Wide-field fundus photograph of an infant
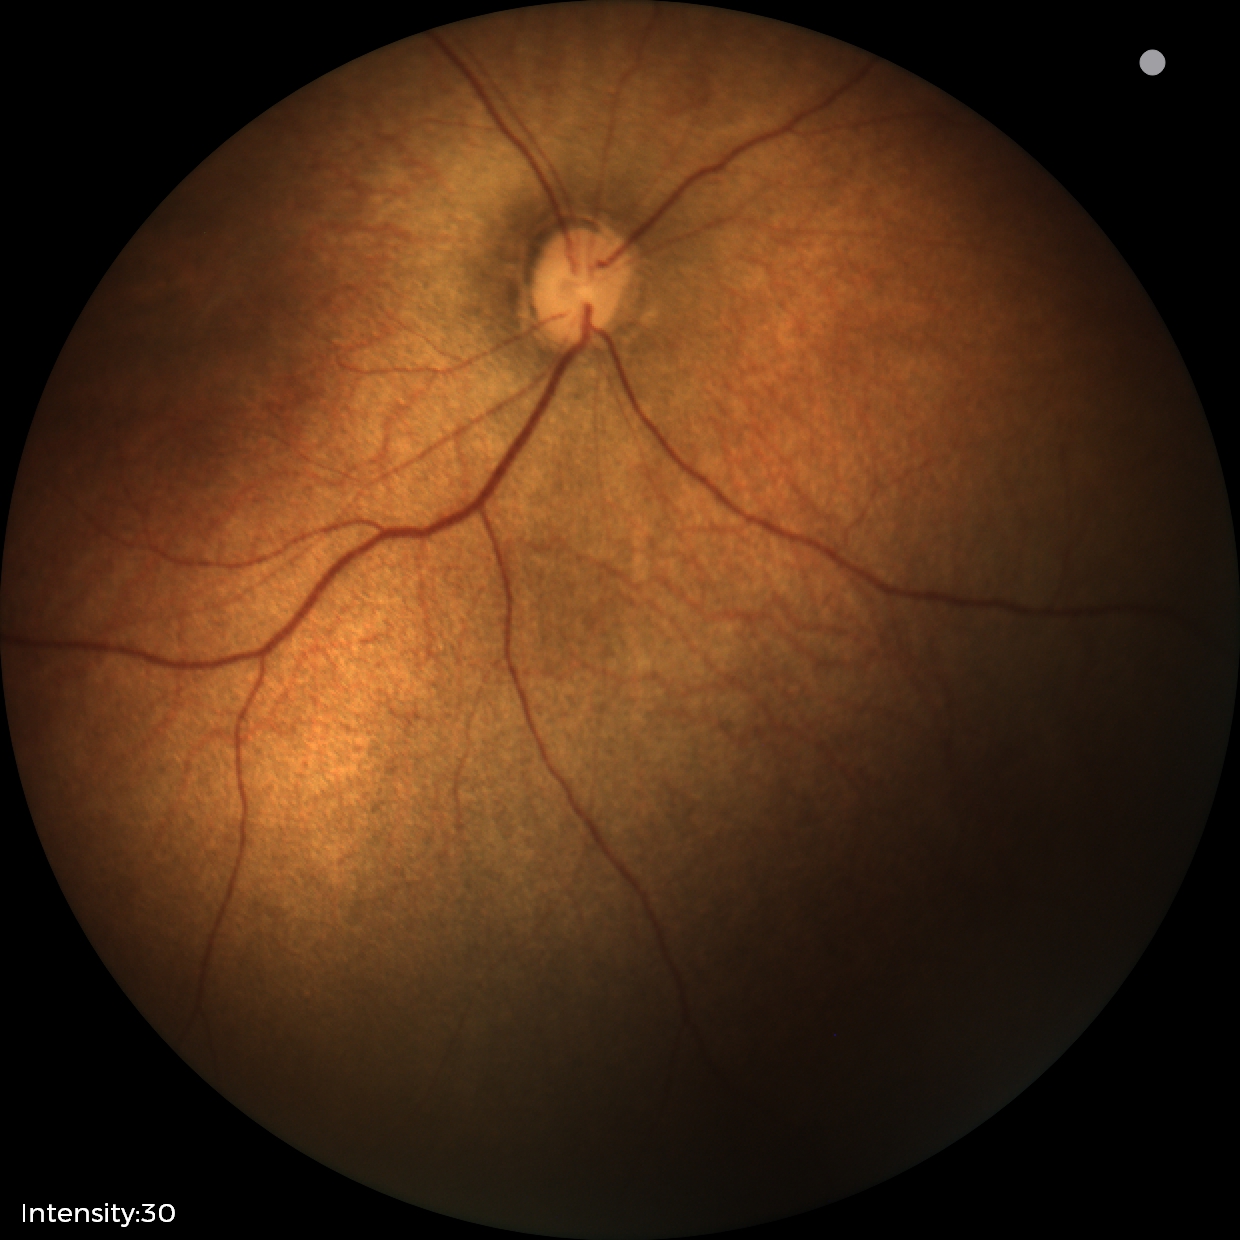 Screening examination with no abnormal retinal findings.